Infant wide-field retinal image. 1240x1240px: 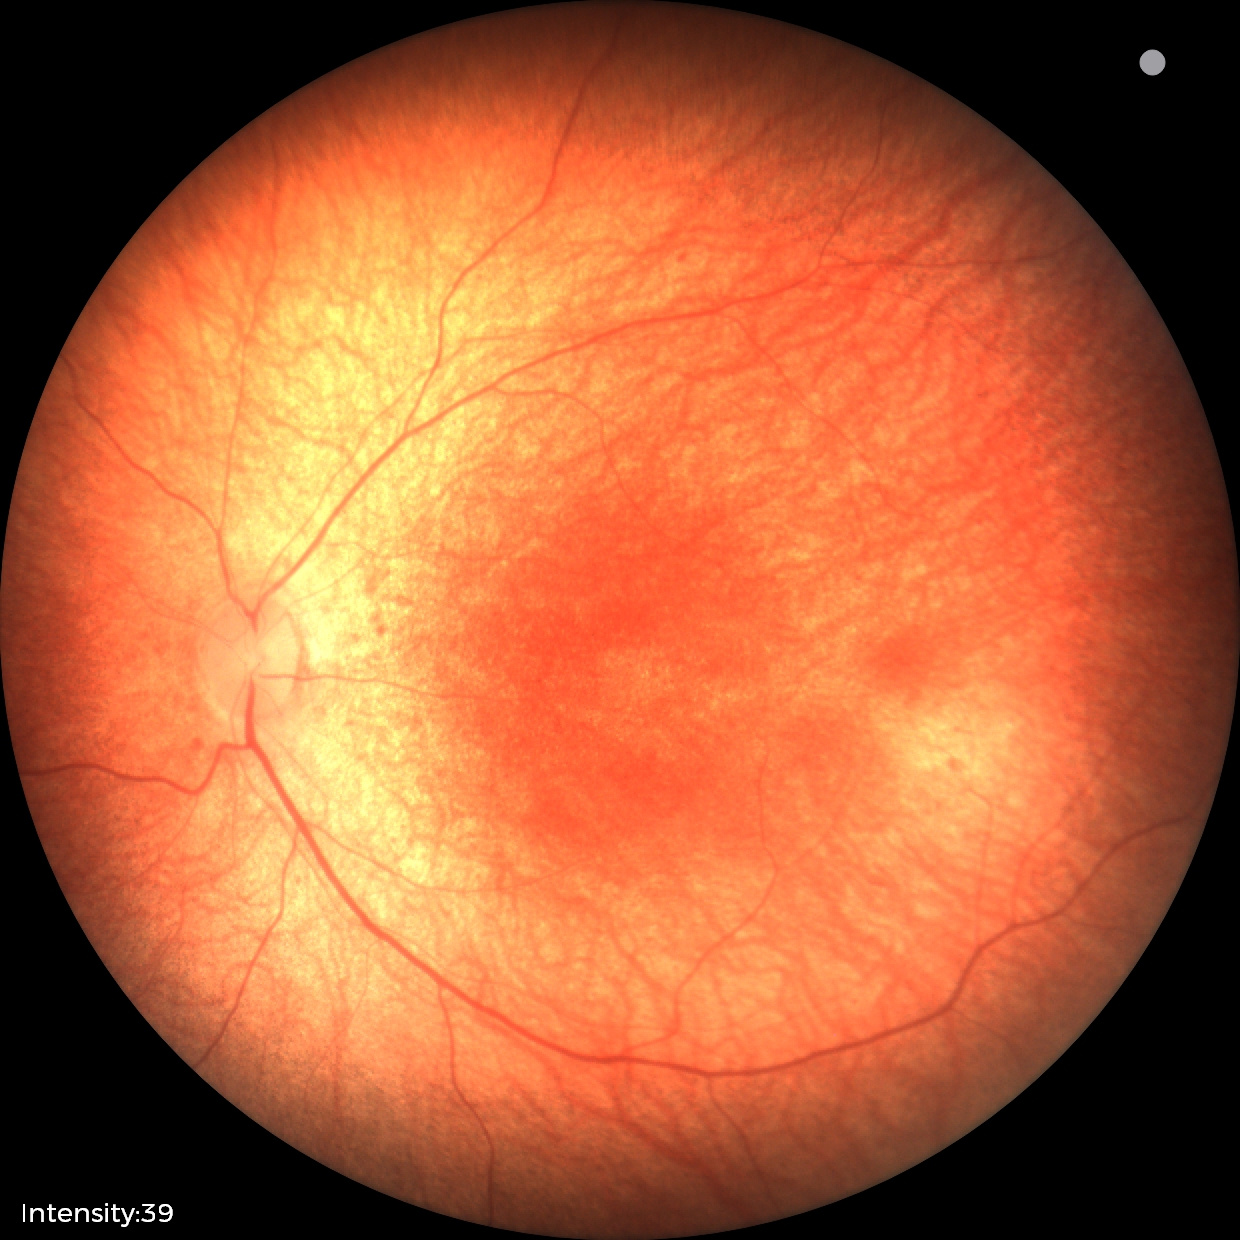 Physiological retinal appearance for postconceptual age.